No pharmacologic dilation; posterior pole photograph; Davis DR grading: 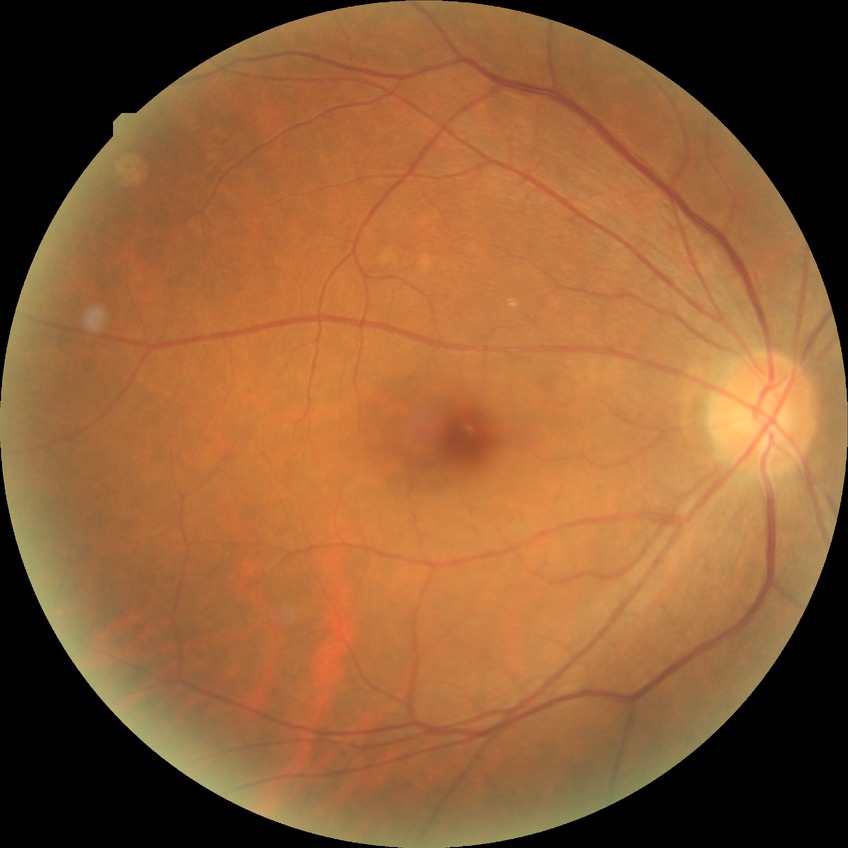
Davis grading is no diabetic retinopathy.